2048 by 1536 pixels, color fundus image.
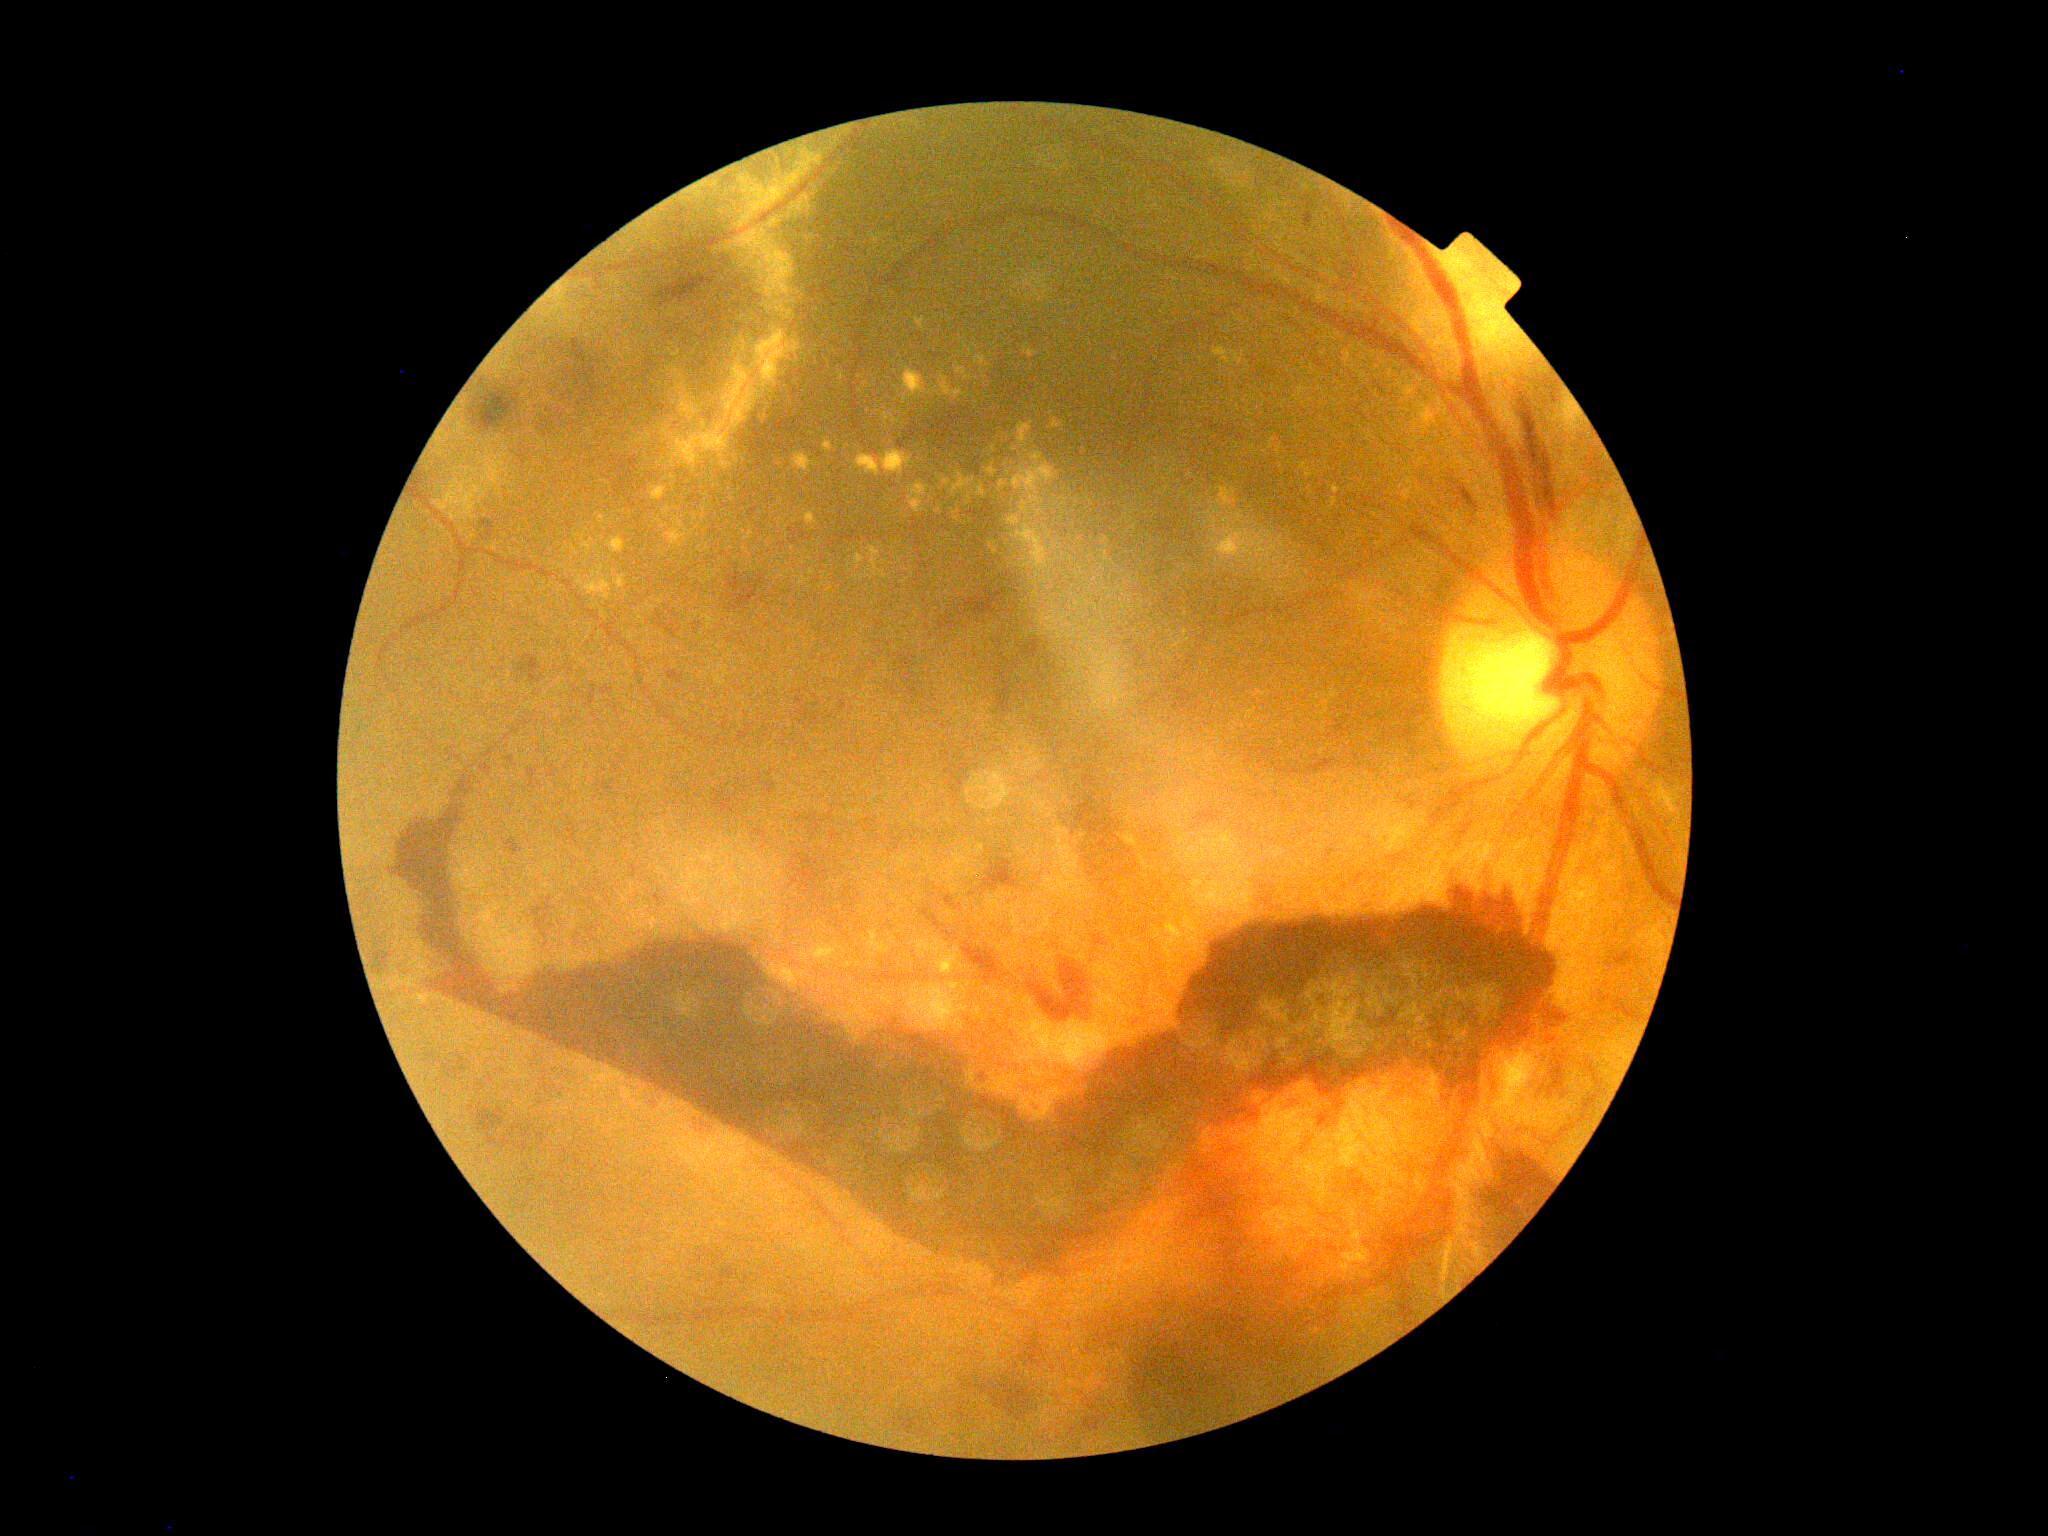

DR class: proliferative diabetic retinopathy.
Diabetic retinopathy severity is 4/4.